Wide-field fundus image from infant ROP screening · camera: Clarity RetCam 3 (130° FOV): 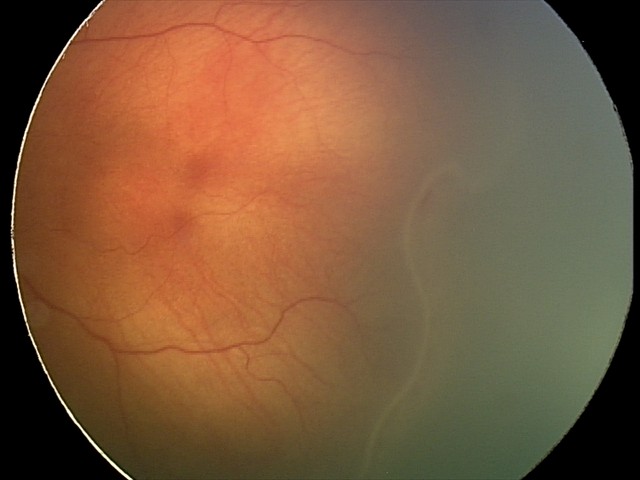
Without plus disease. Screening examination consistent with retinopathy of prematurity stage 2.